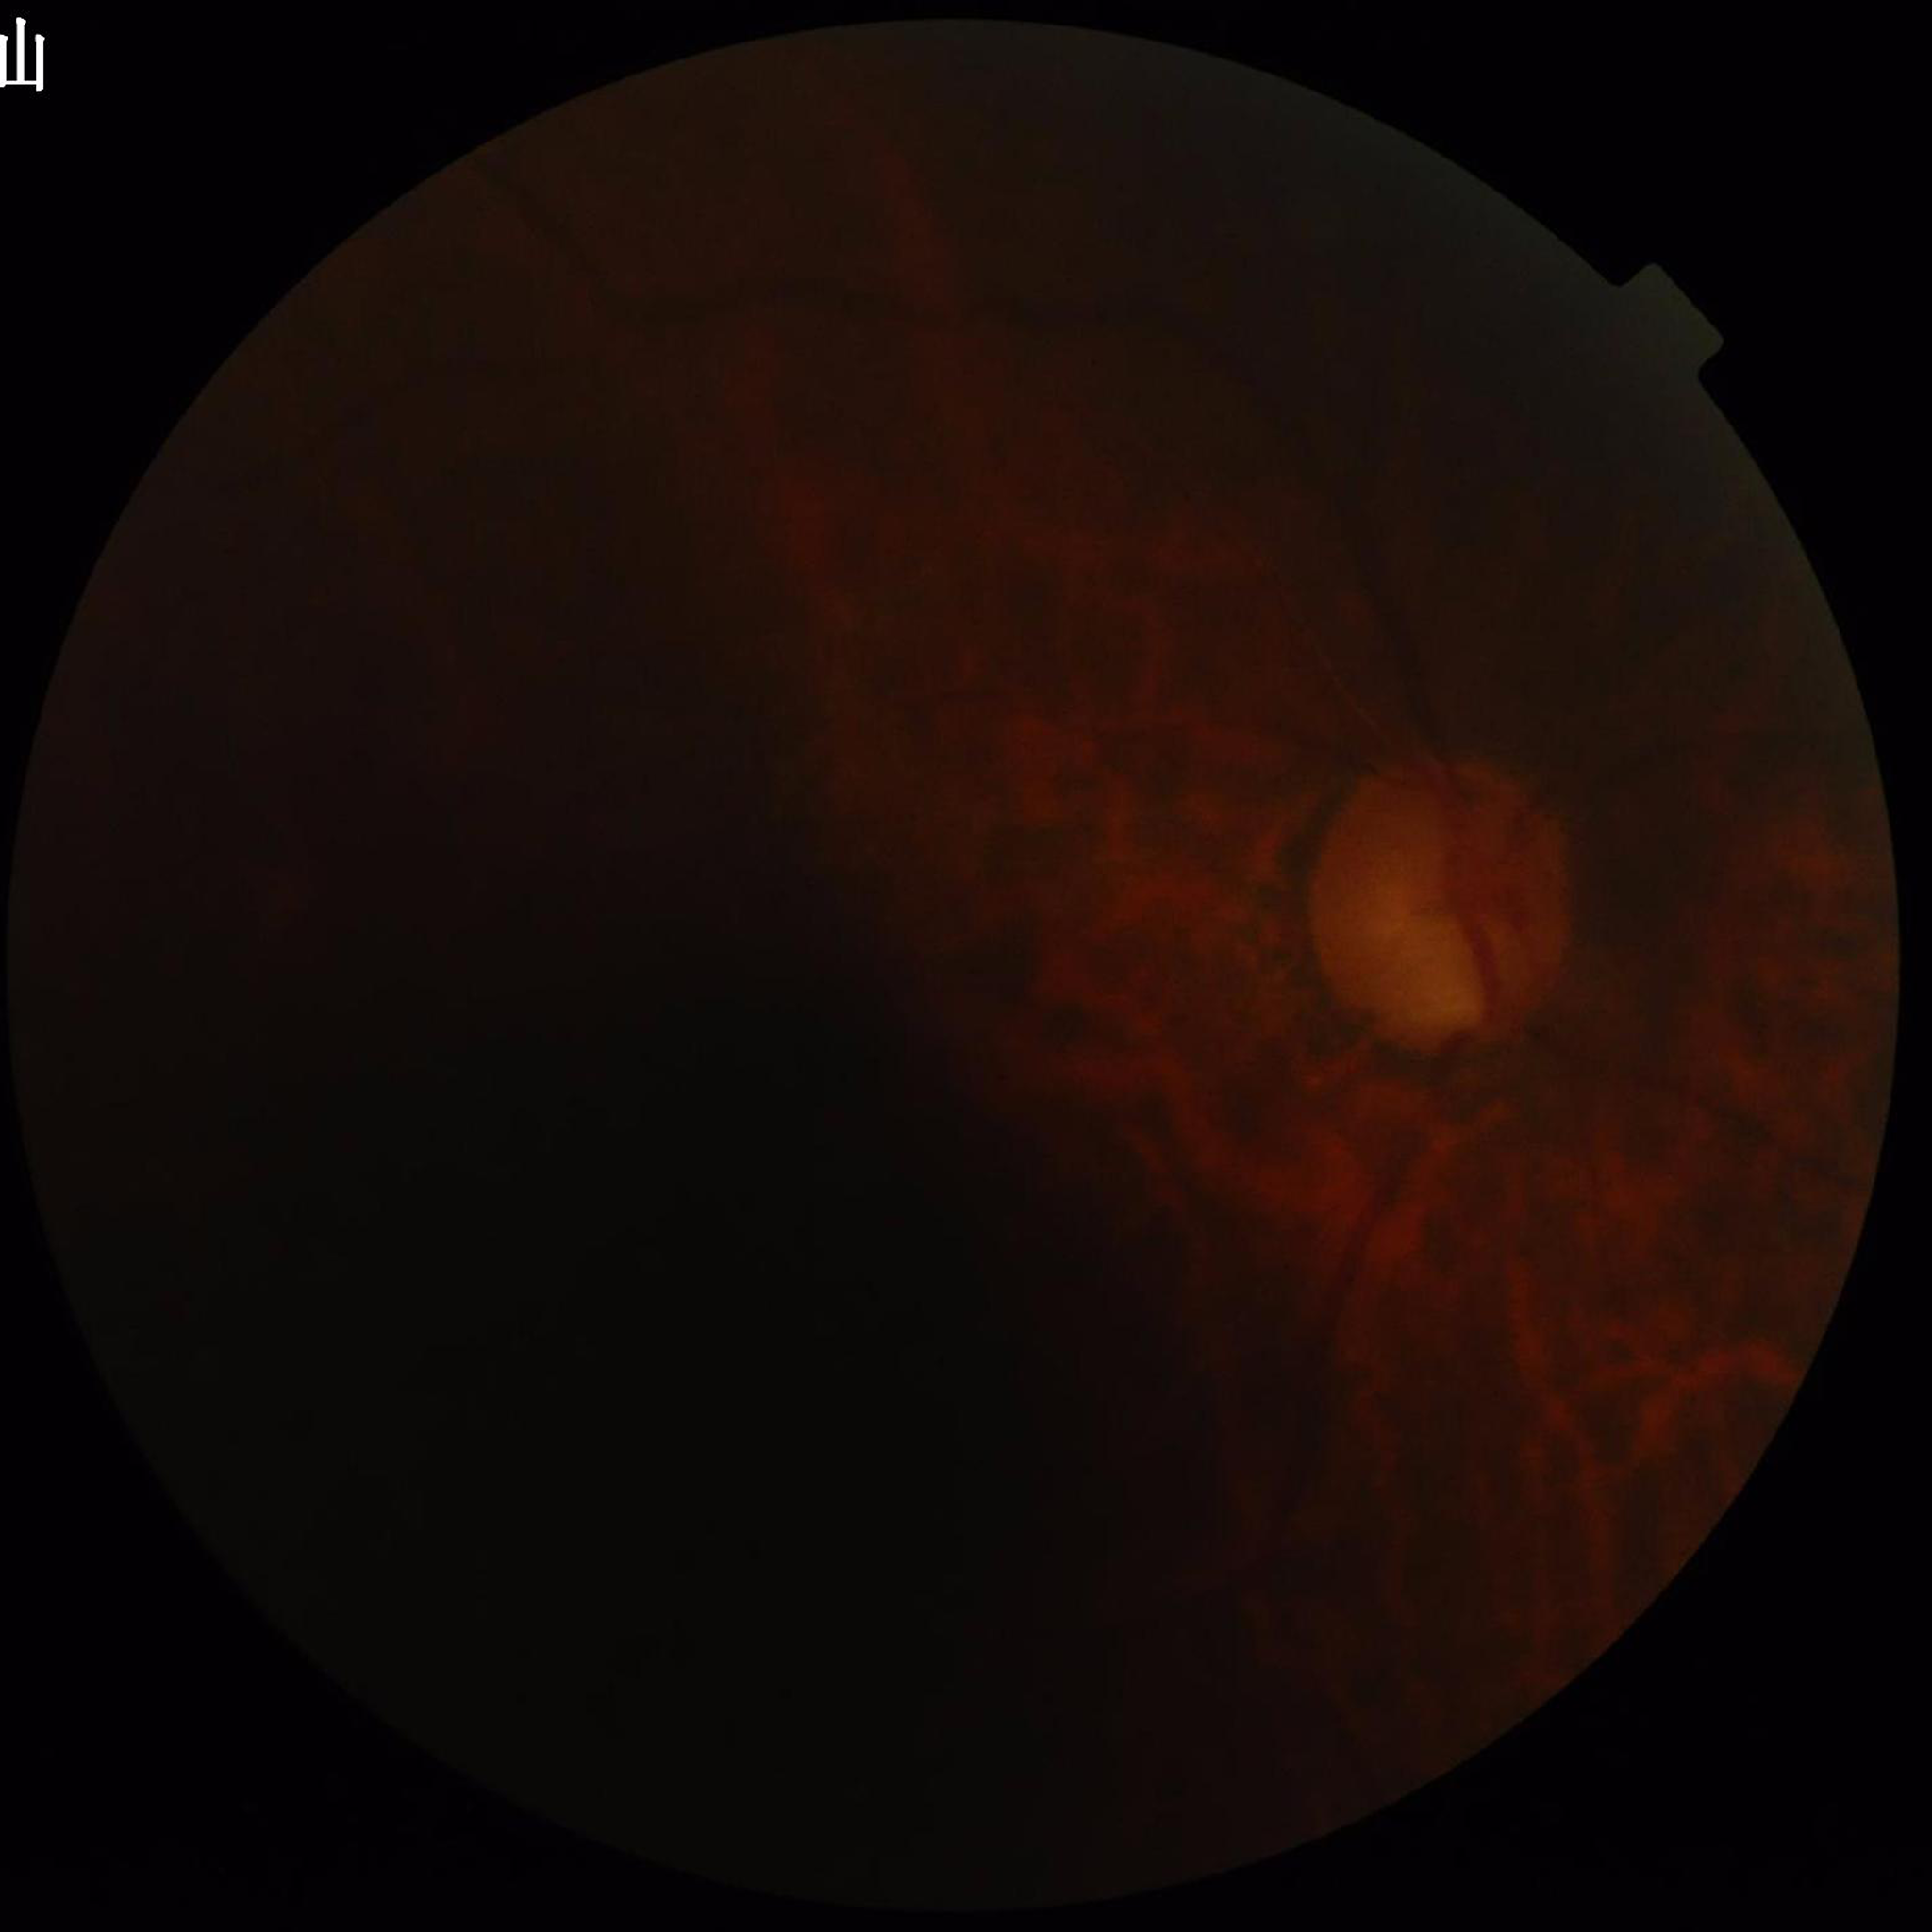

Automated quality assessment: illumination/color distortion present, blur present, low contrast.
From a patient with glaucoma.